Retinal fundus photograph. 2212 x 1659 pixels
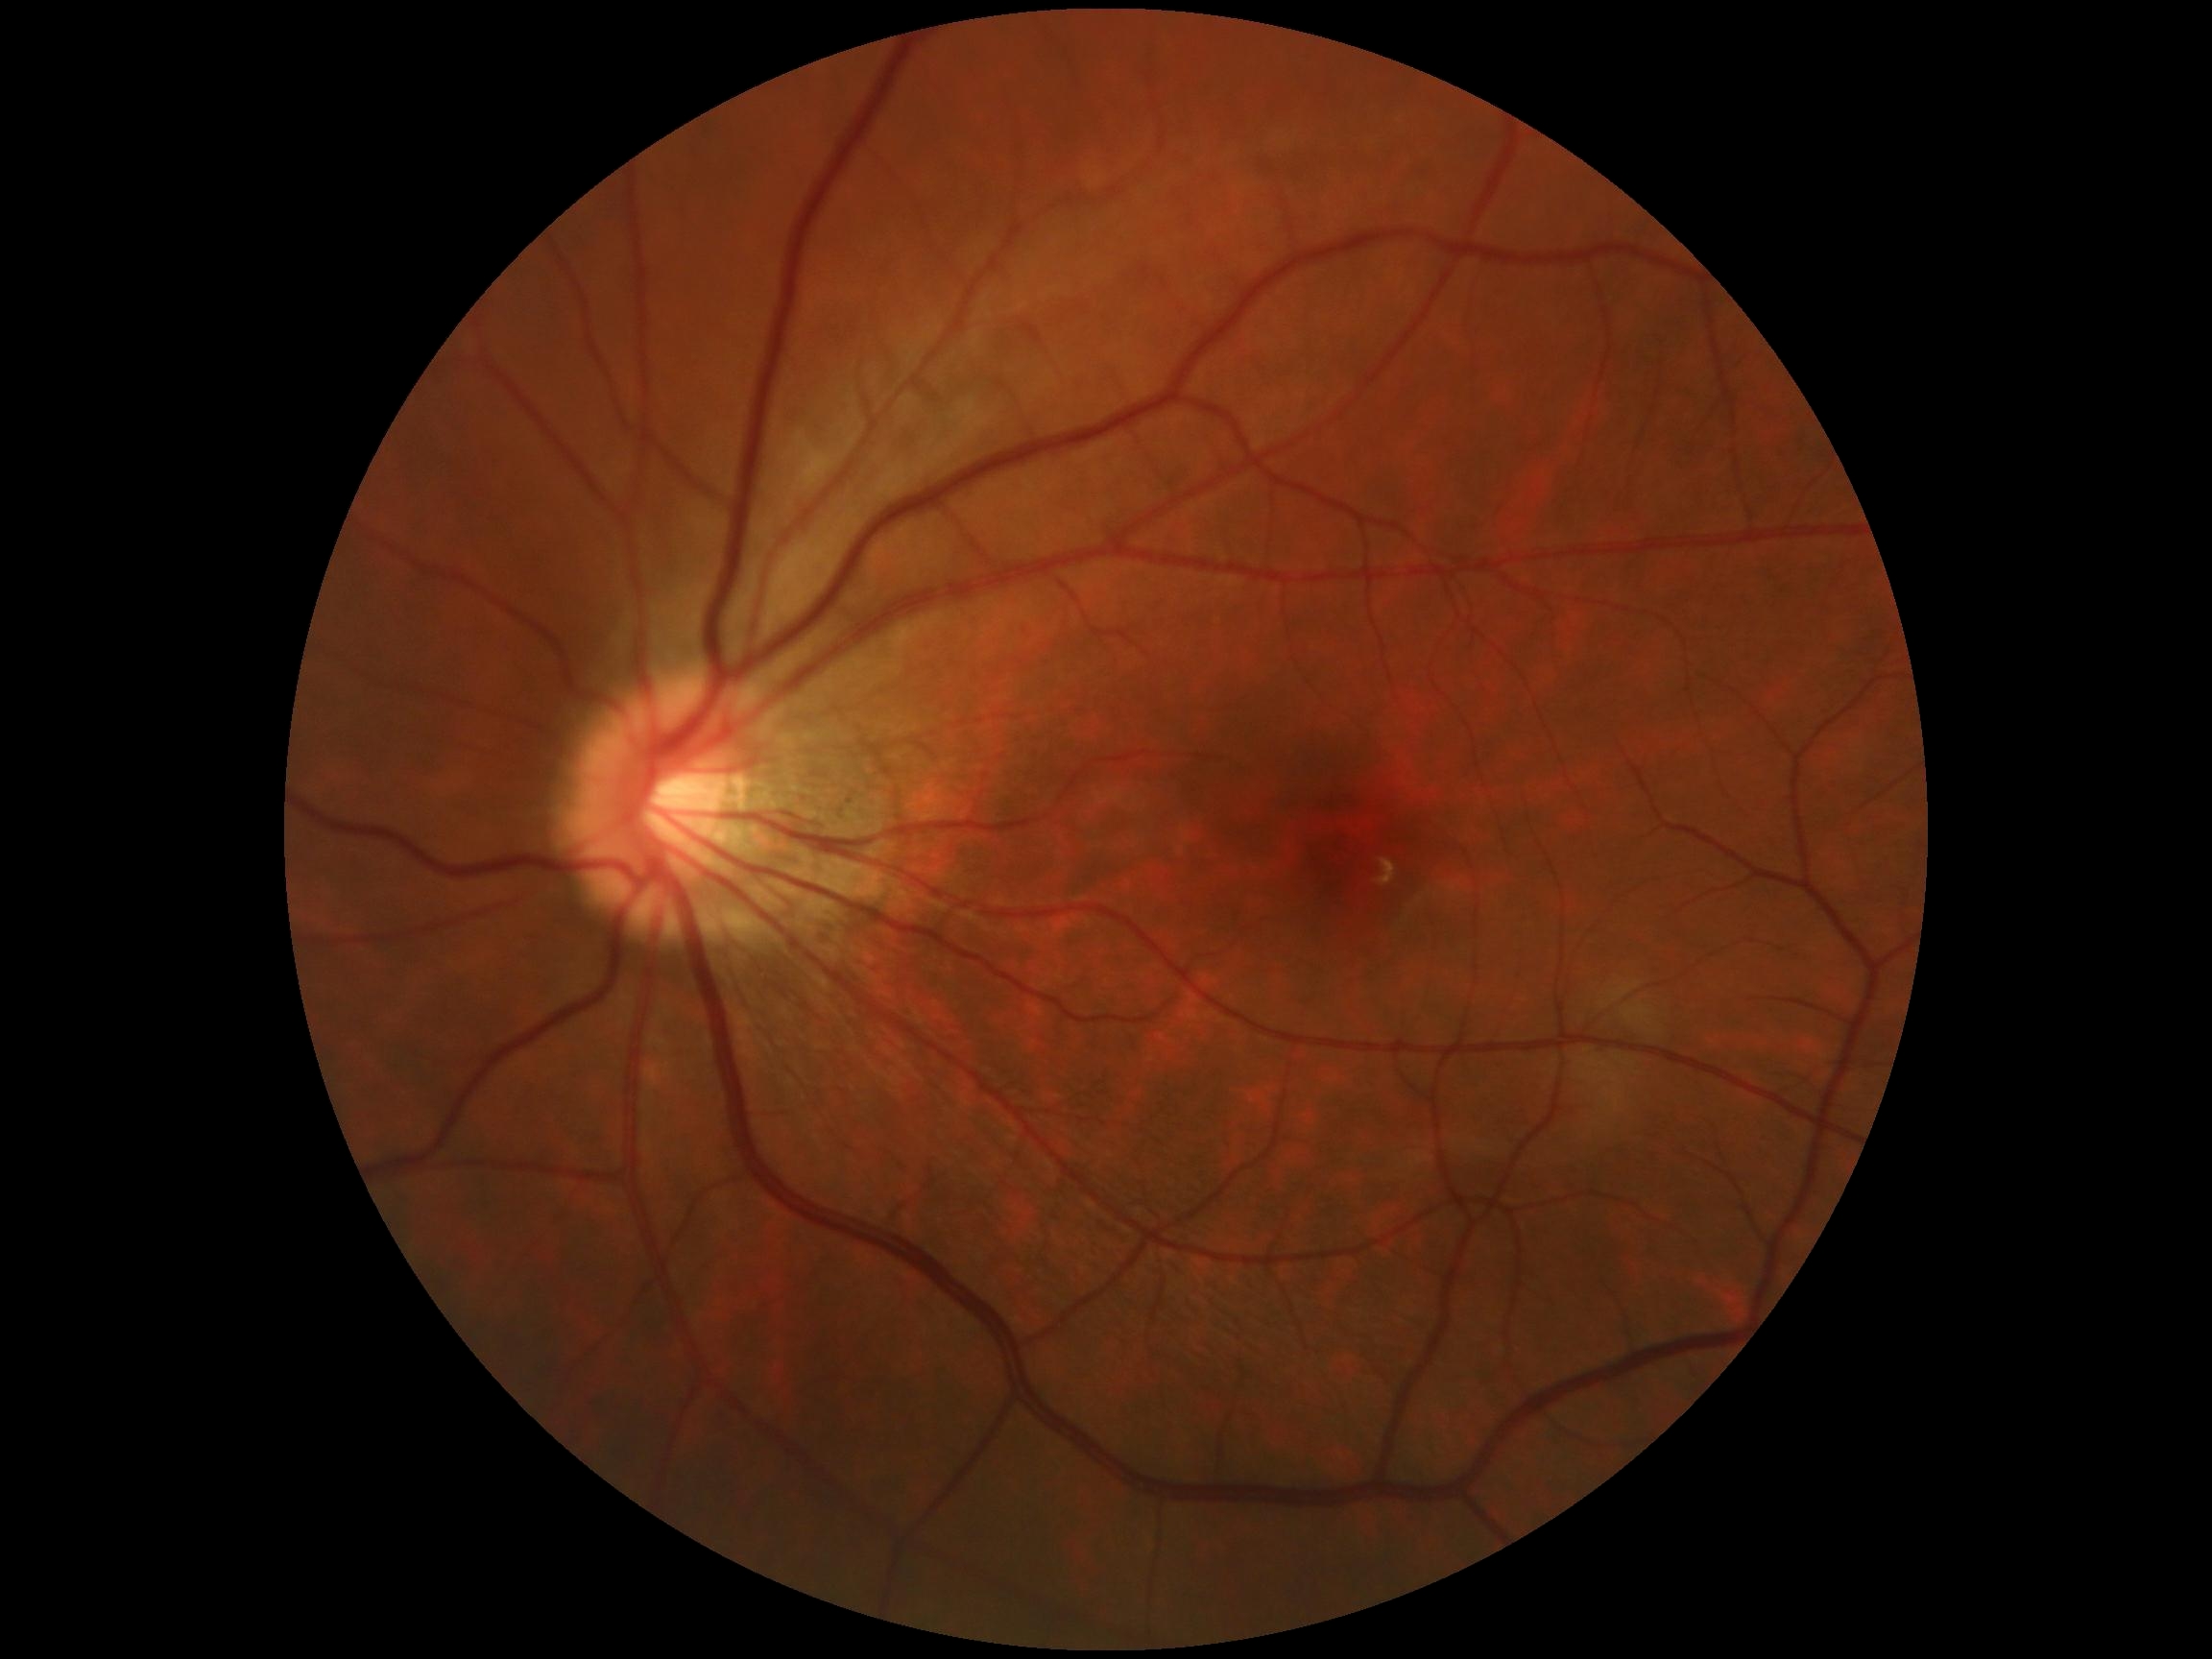

DR impression: no signs of DR | diabetic retinopathy severity: grade 0 (no apparent retinopathy).